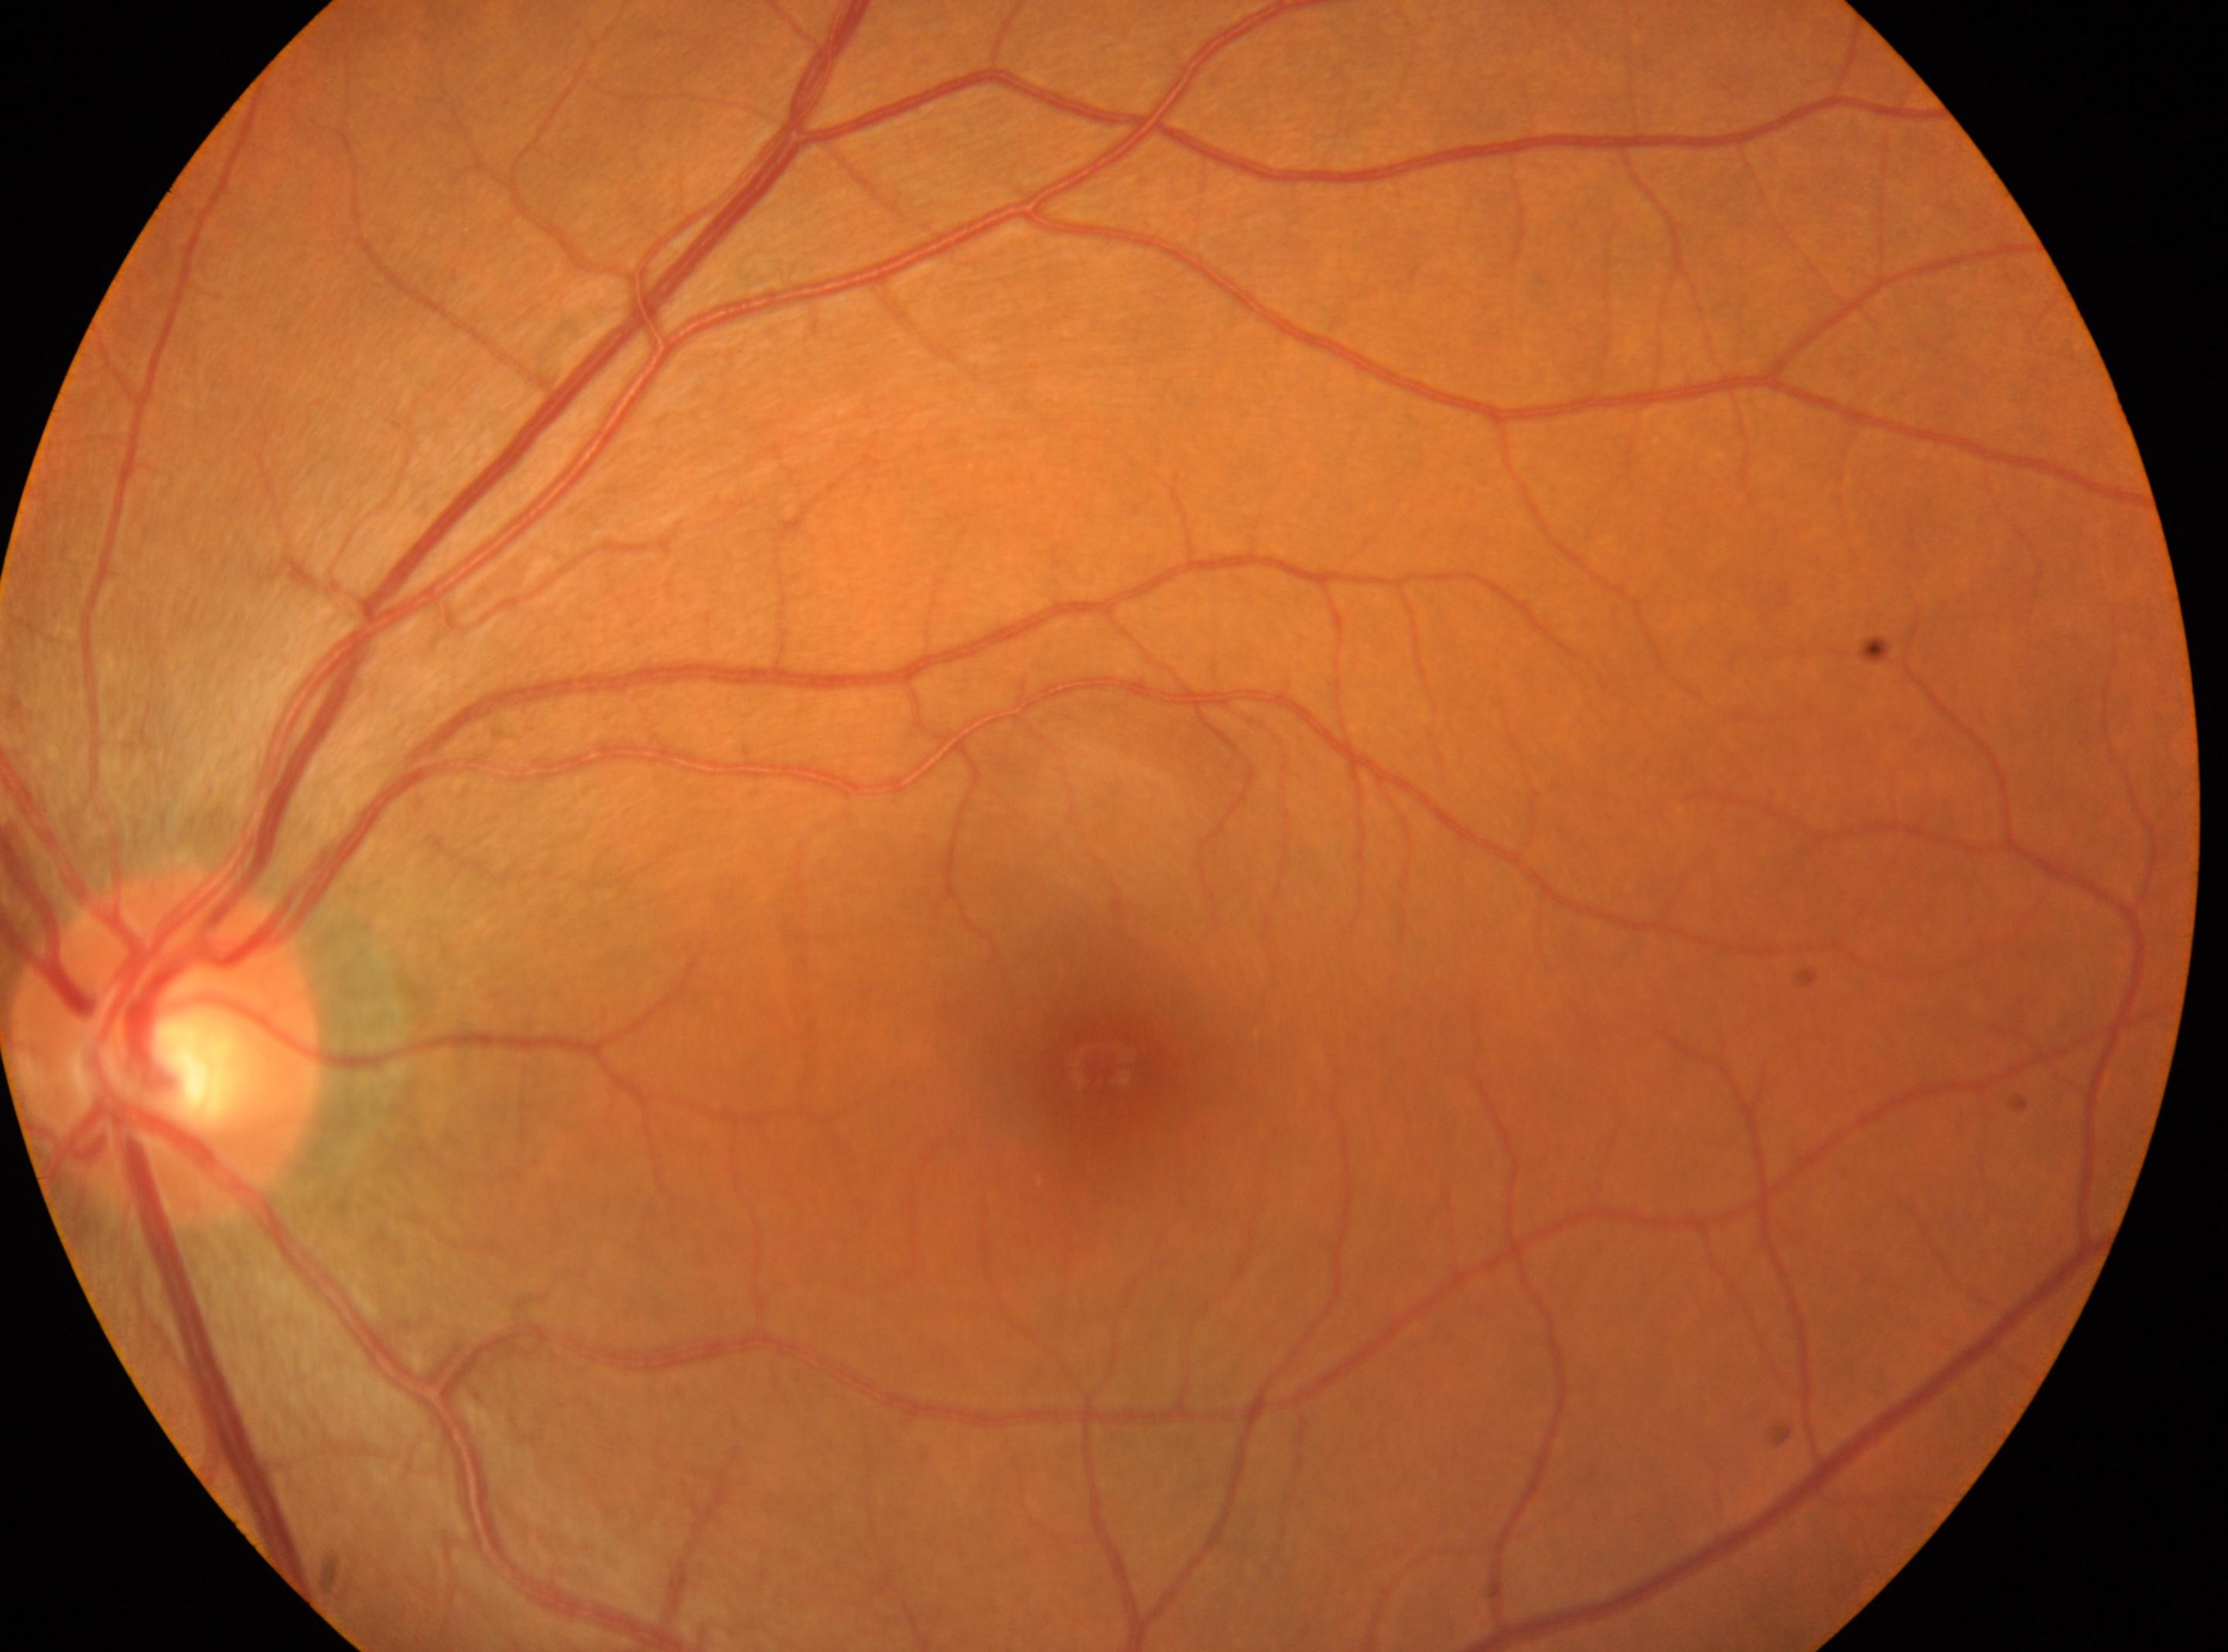
Findings:
- laterality — left eye
- DR stage — 0
- optic disk — (167,1047)
- fovea center — (1099,1063)